Central corneal thickness: 556 µm. Intraocular pressure (IOP) (non-contact tonometry): 15 mmHg. Axial length 27.53 mm. Camera: Topcon TRC-NW400. Refractive error: -6.75 -0.5 x 106. Gender: F: 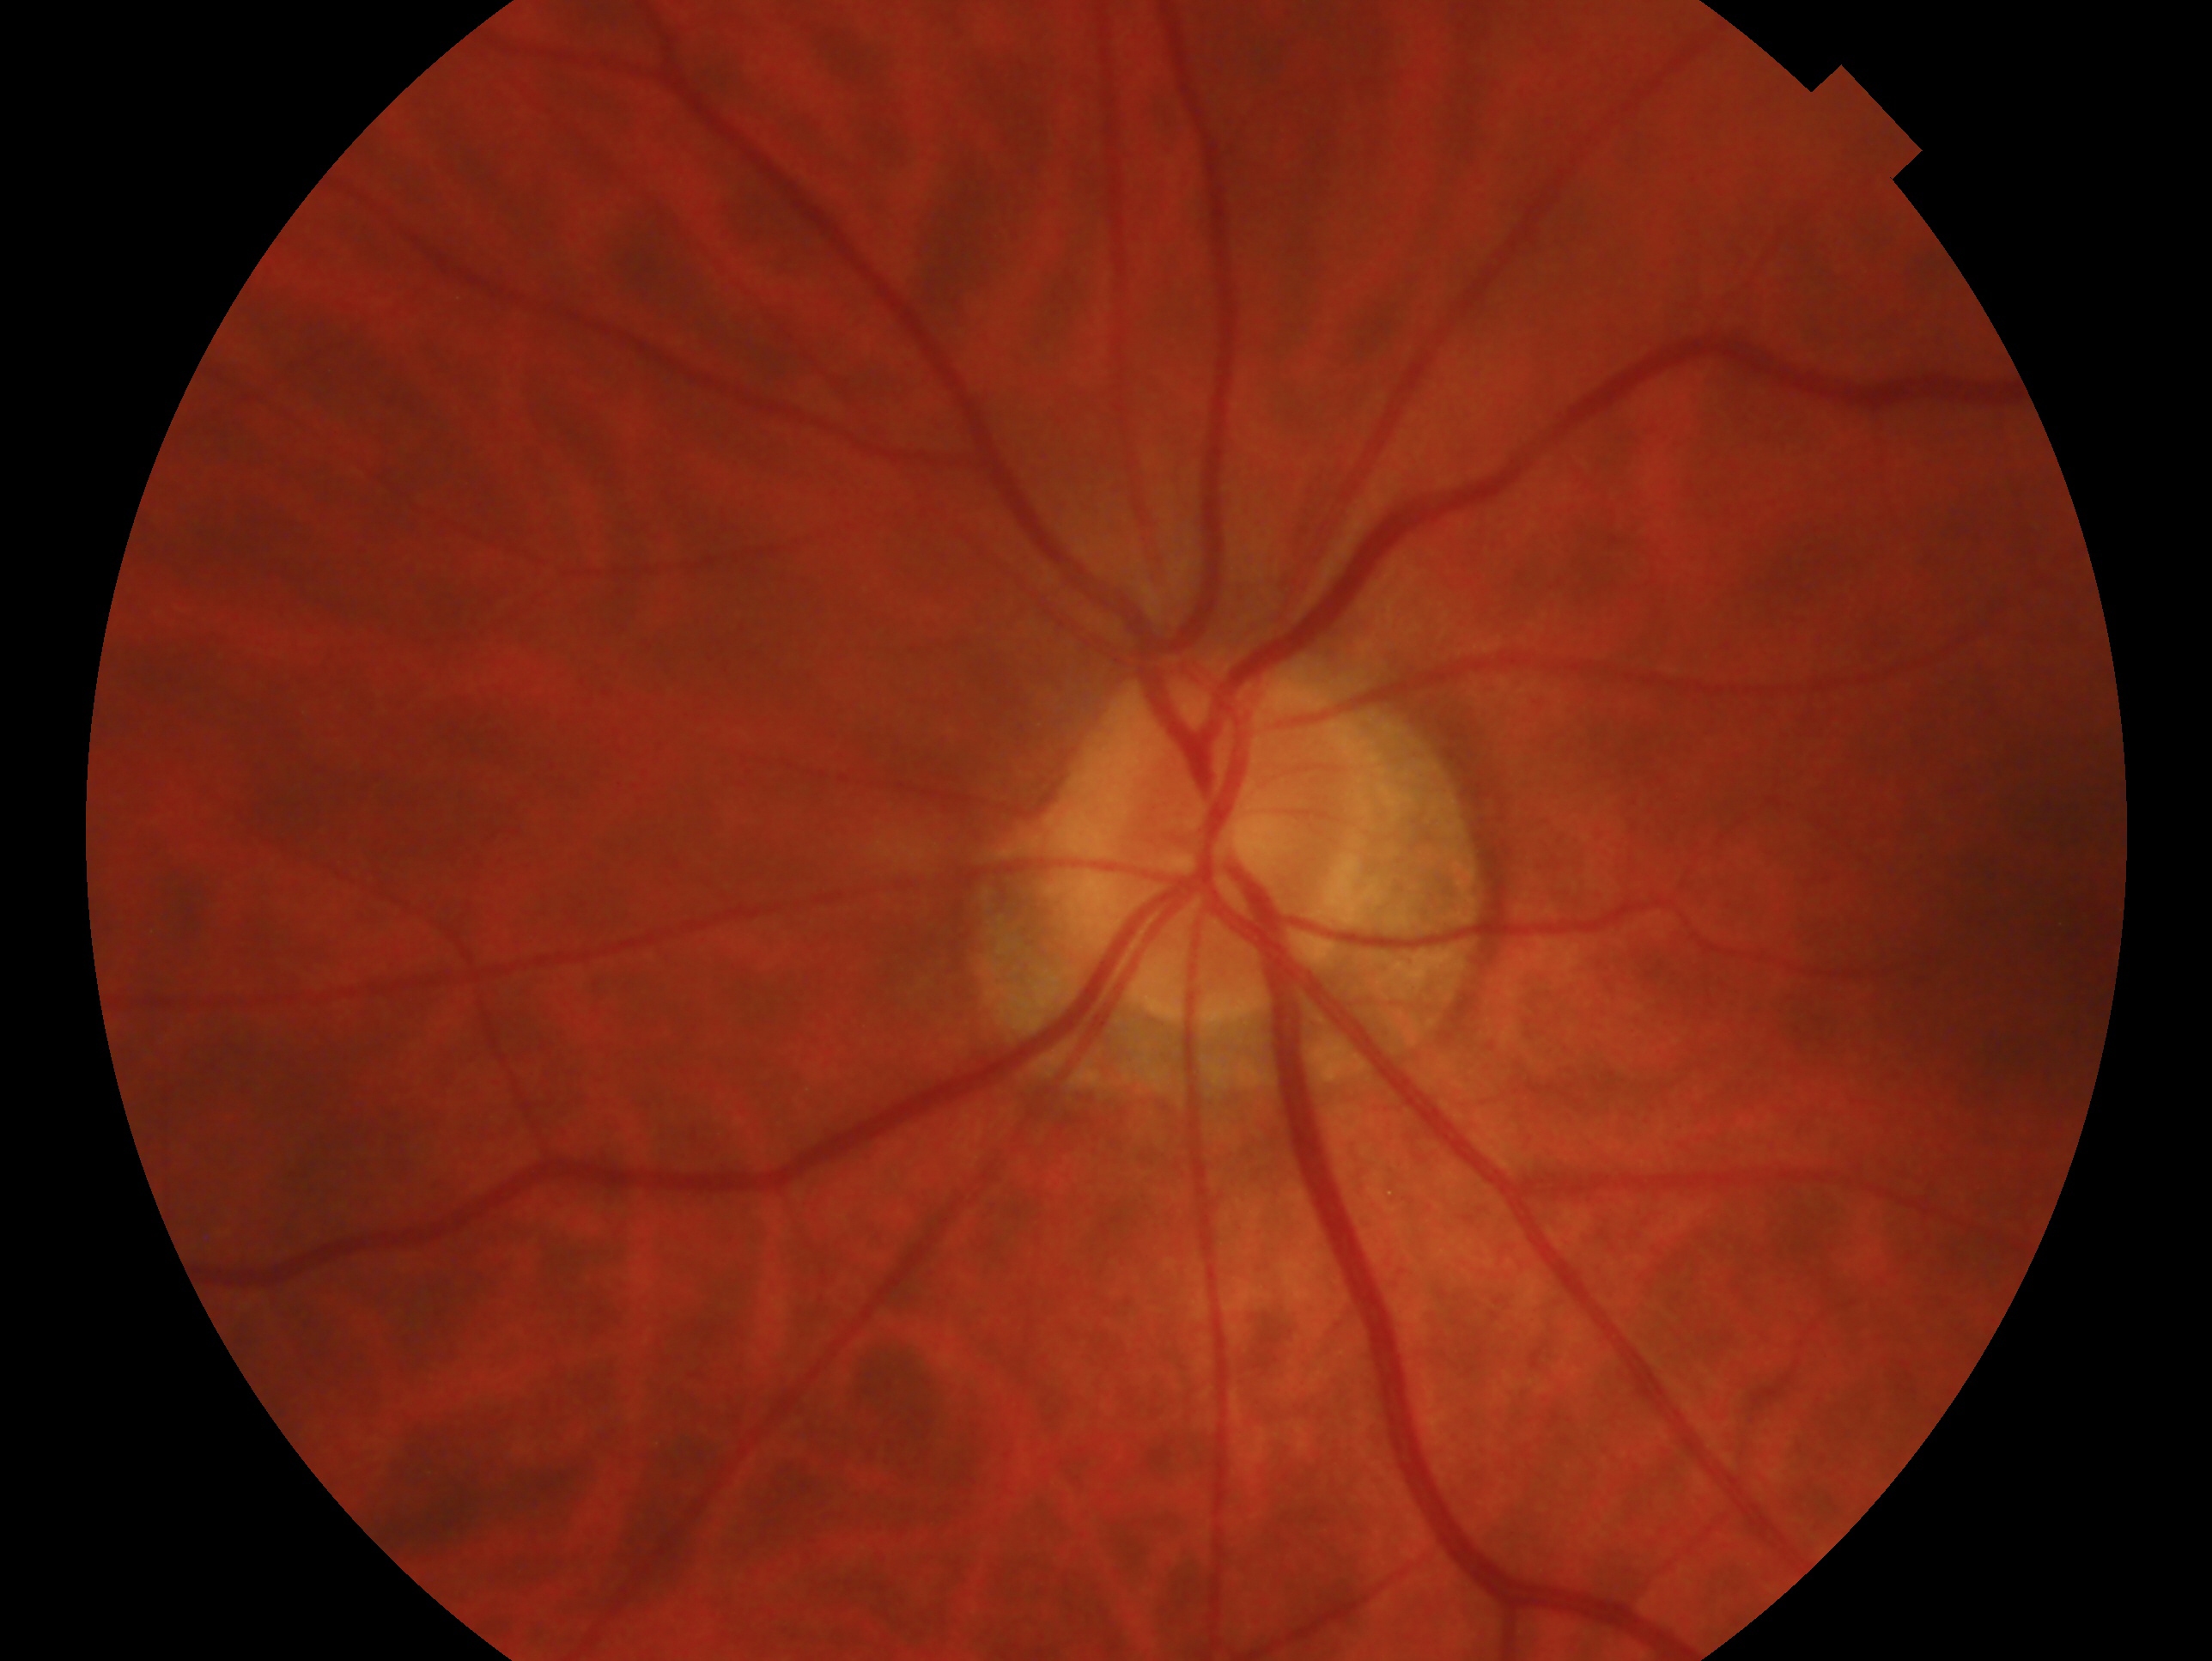 glaucoma status: no glaucoma
laterality: left